Male patient; fundus photo — 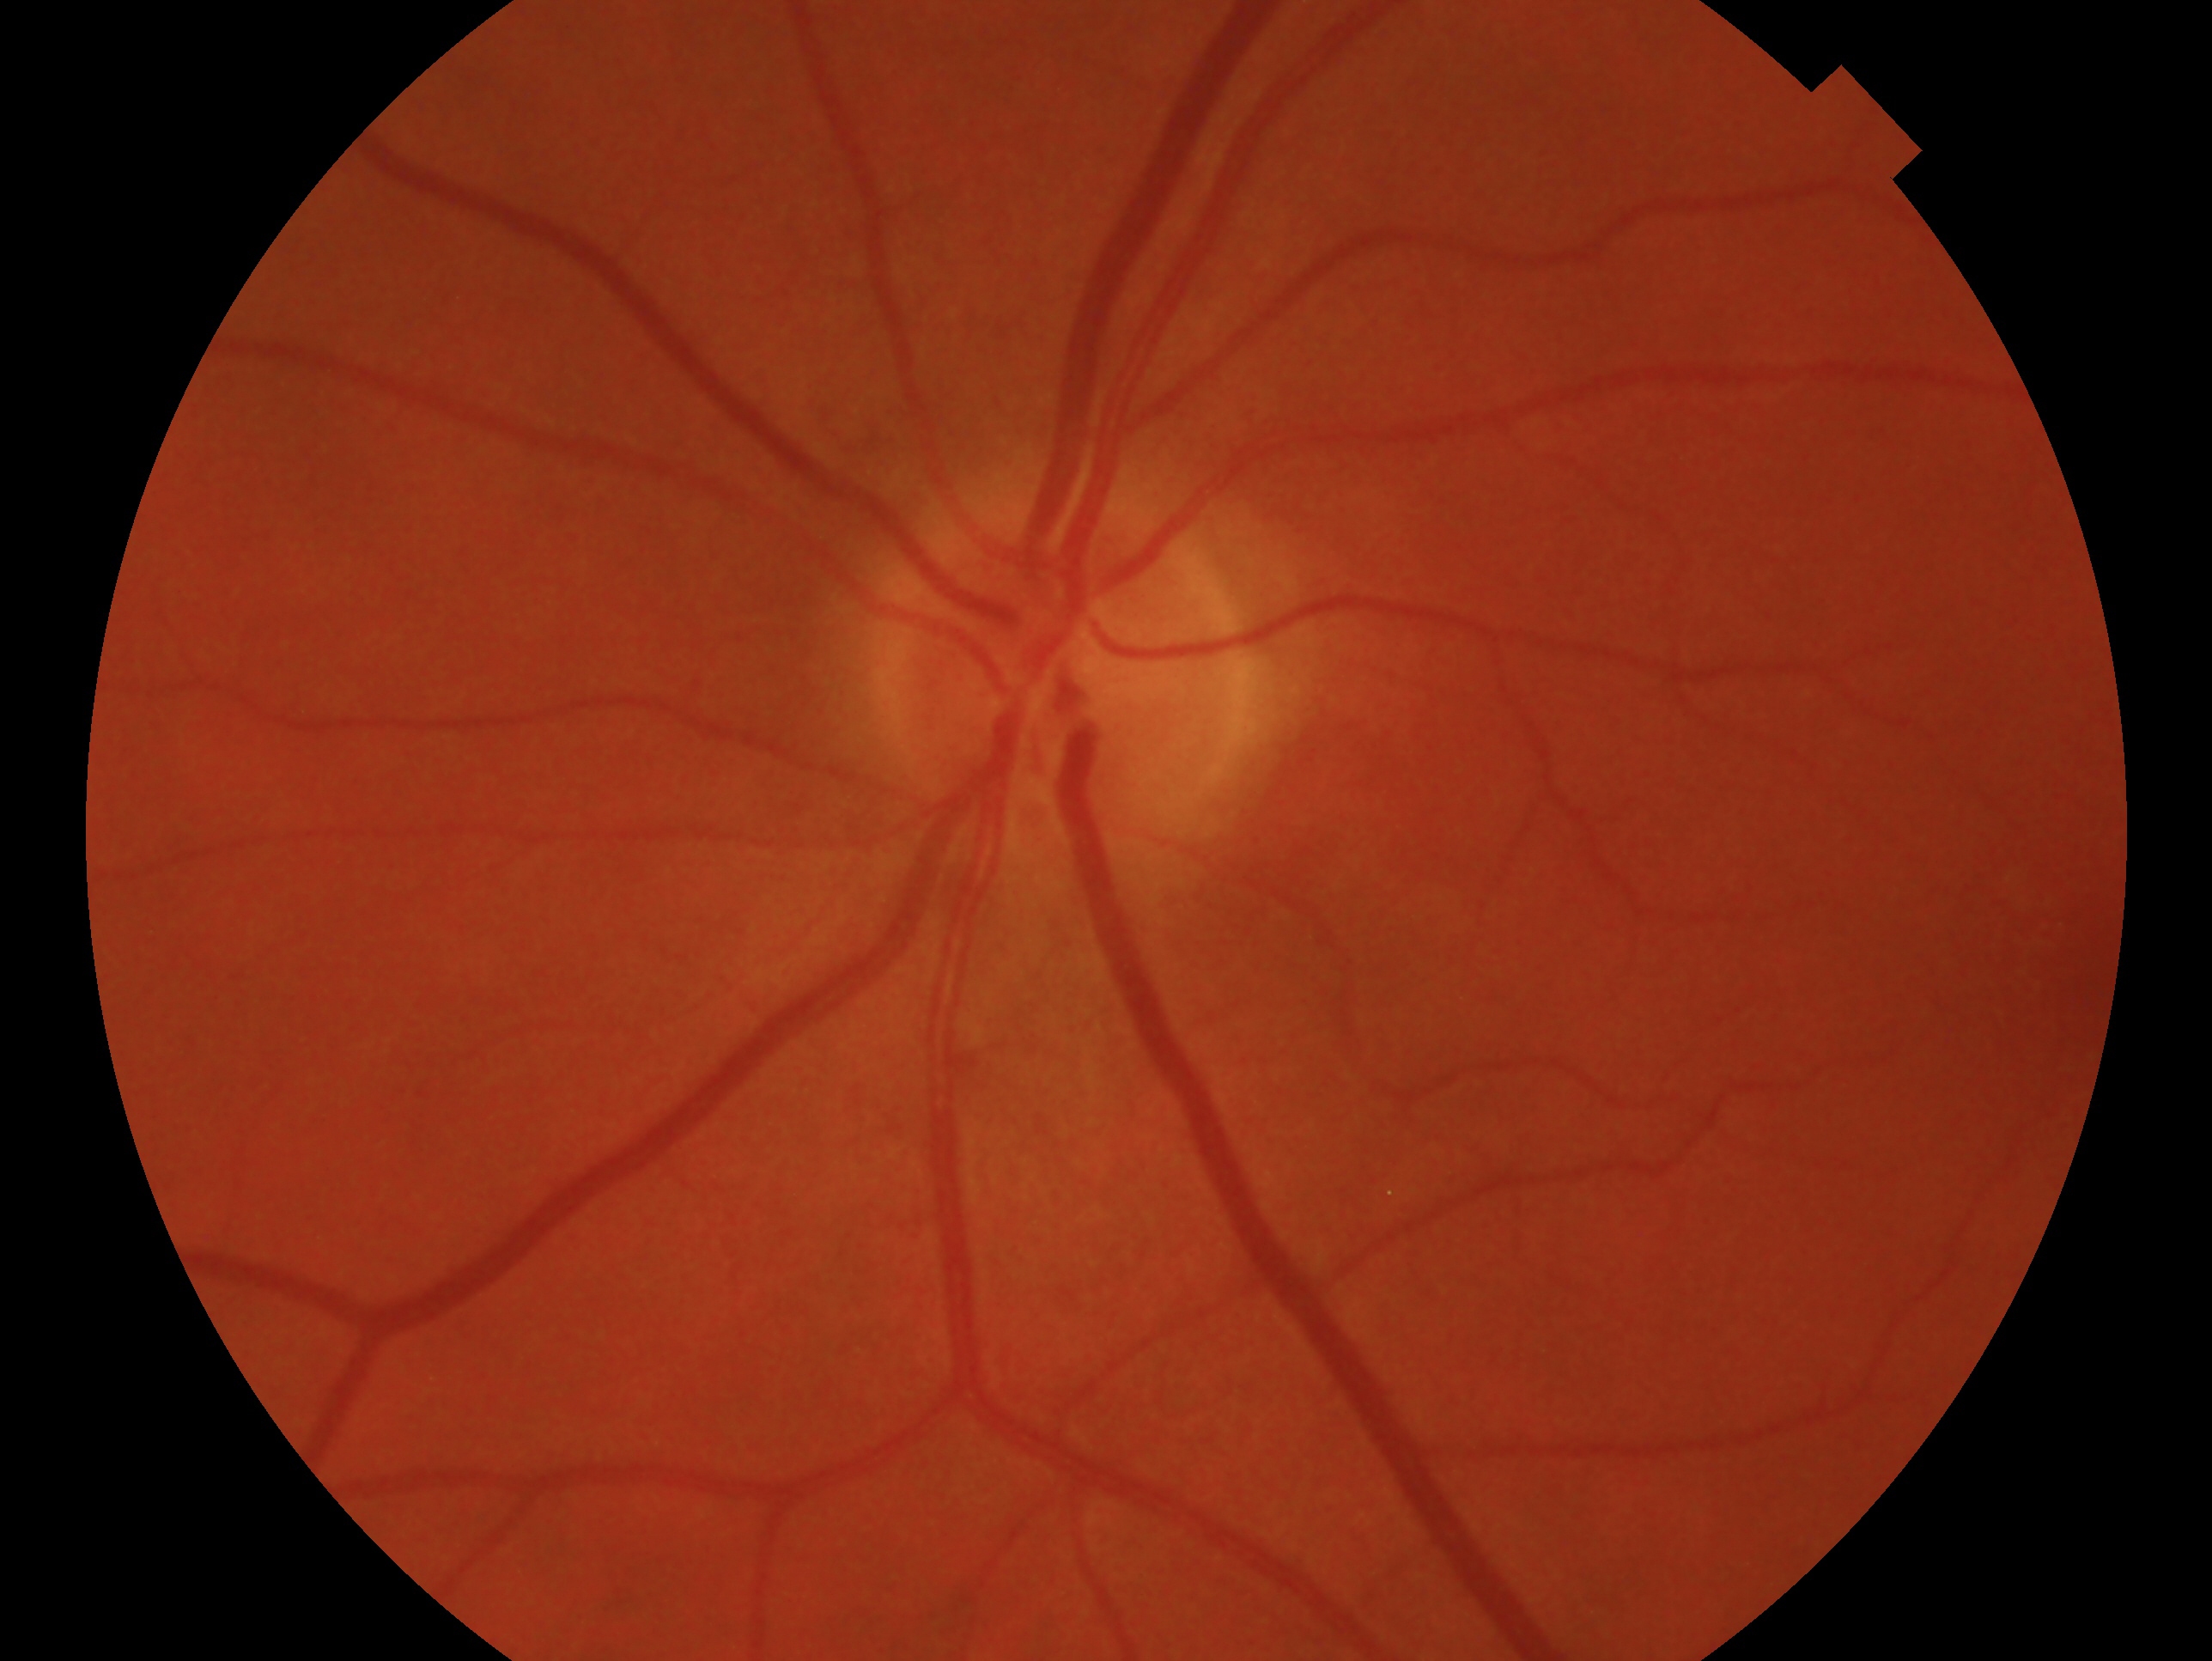 This is the left eye. Glaucoma diagnosis: no signs of glaucoma.